No pharmacologic dilation; graded on the modified Davis scale; posterior pole color fundus photograph; 848x848px: 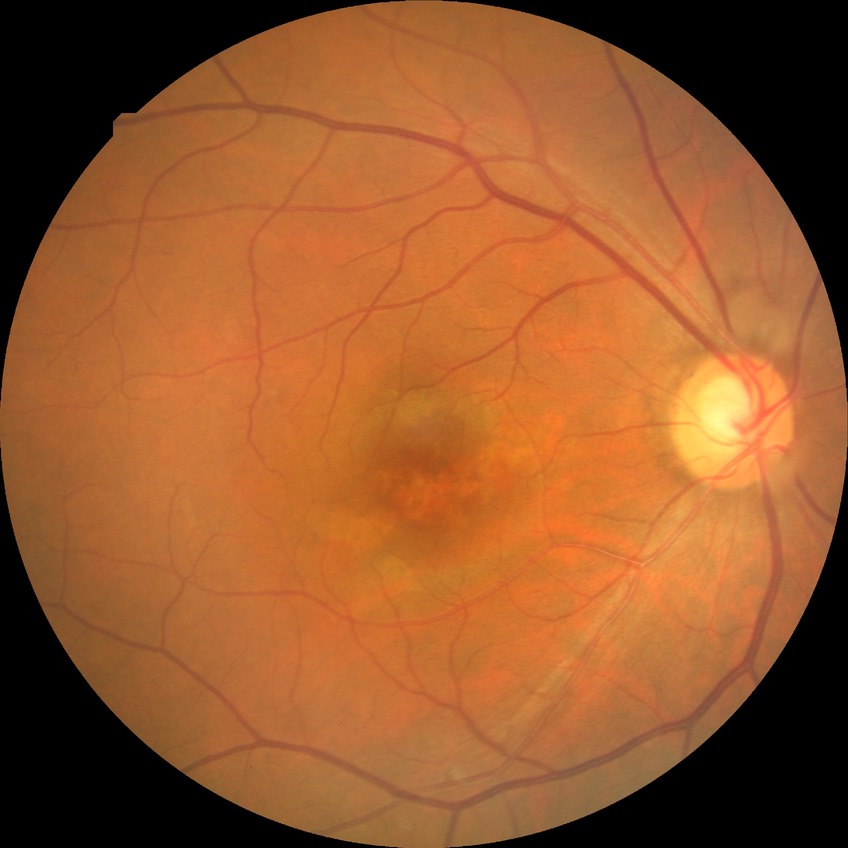 Diabetic retinopathy (DR) is NDR (no diabetic retinopathy).